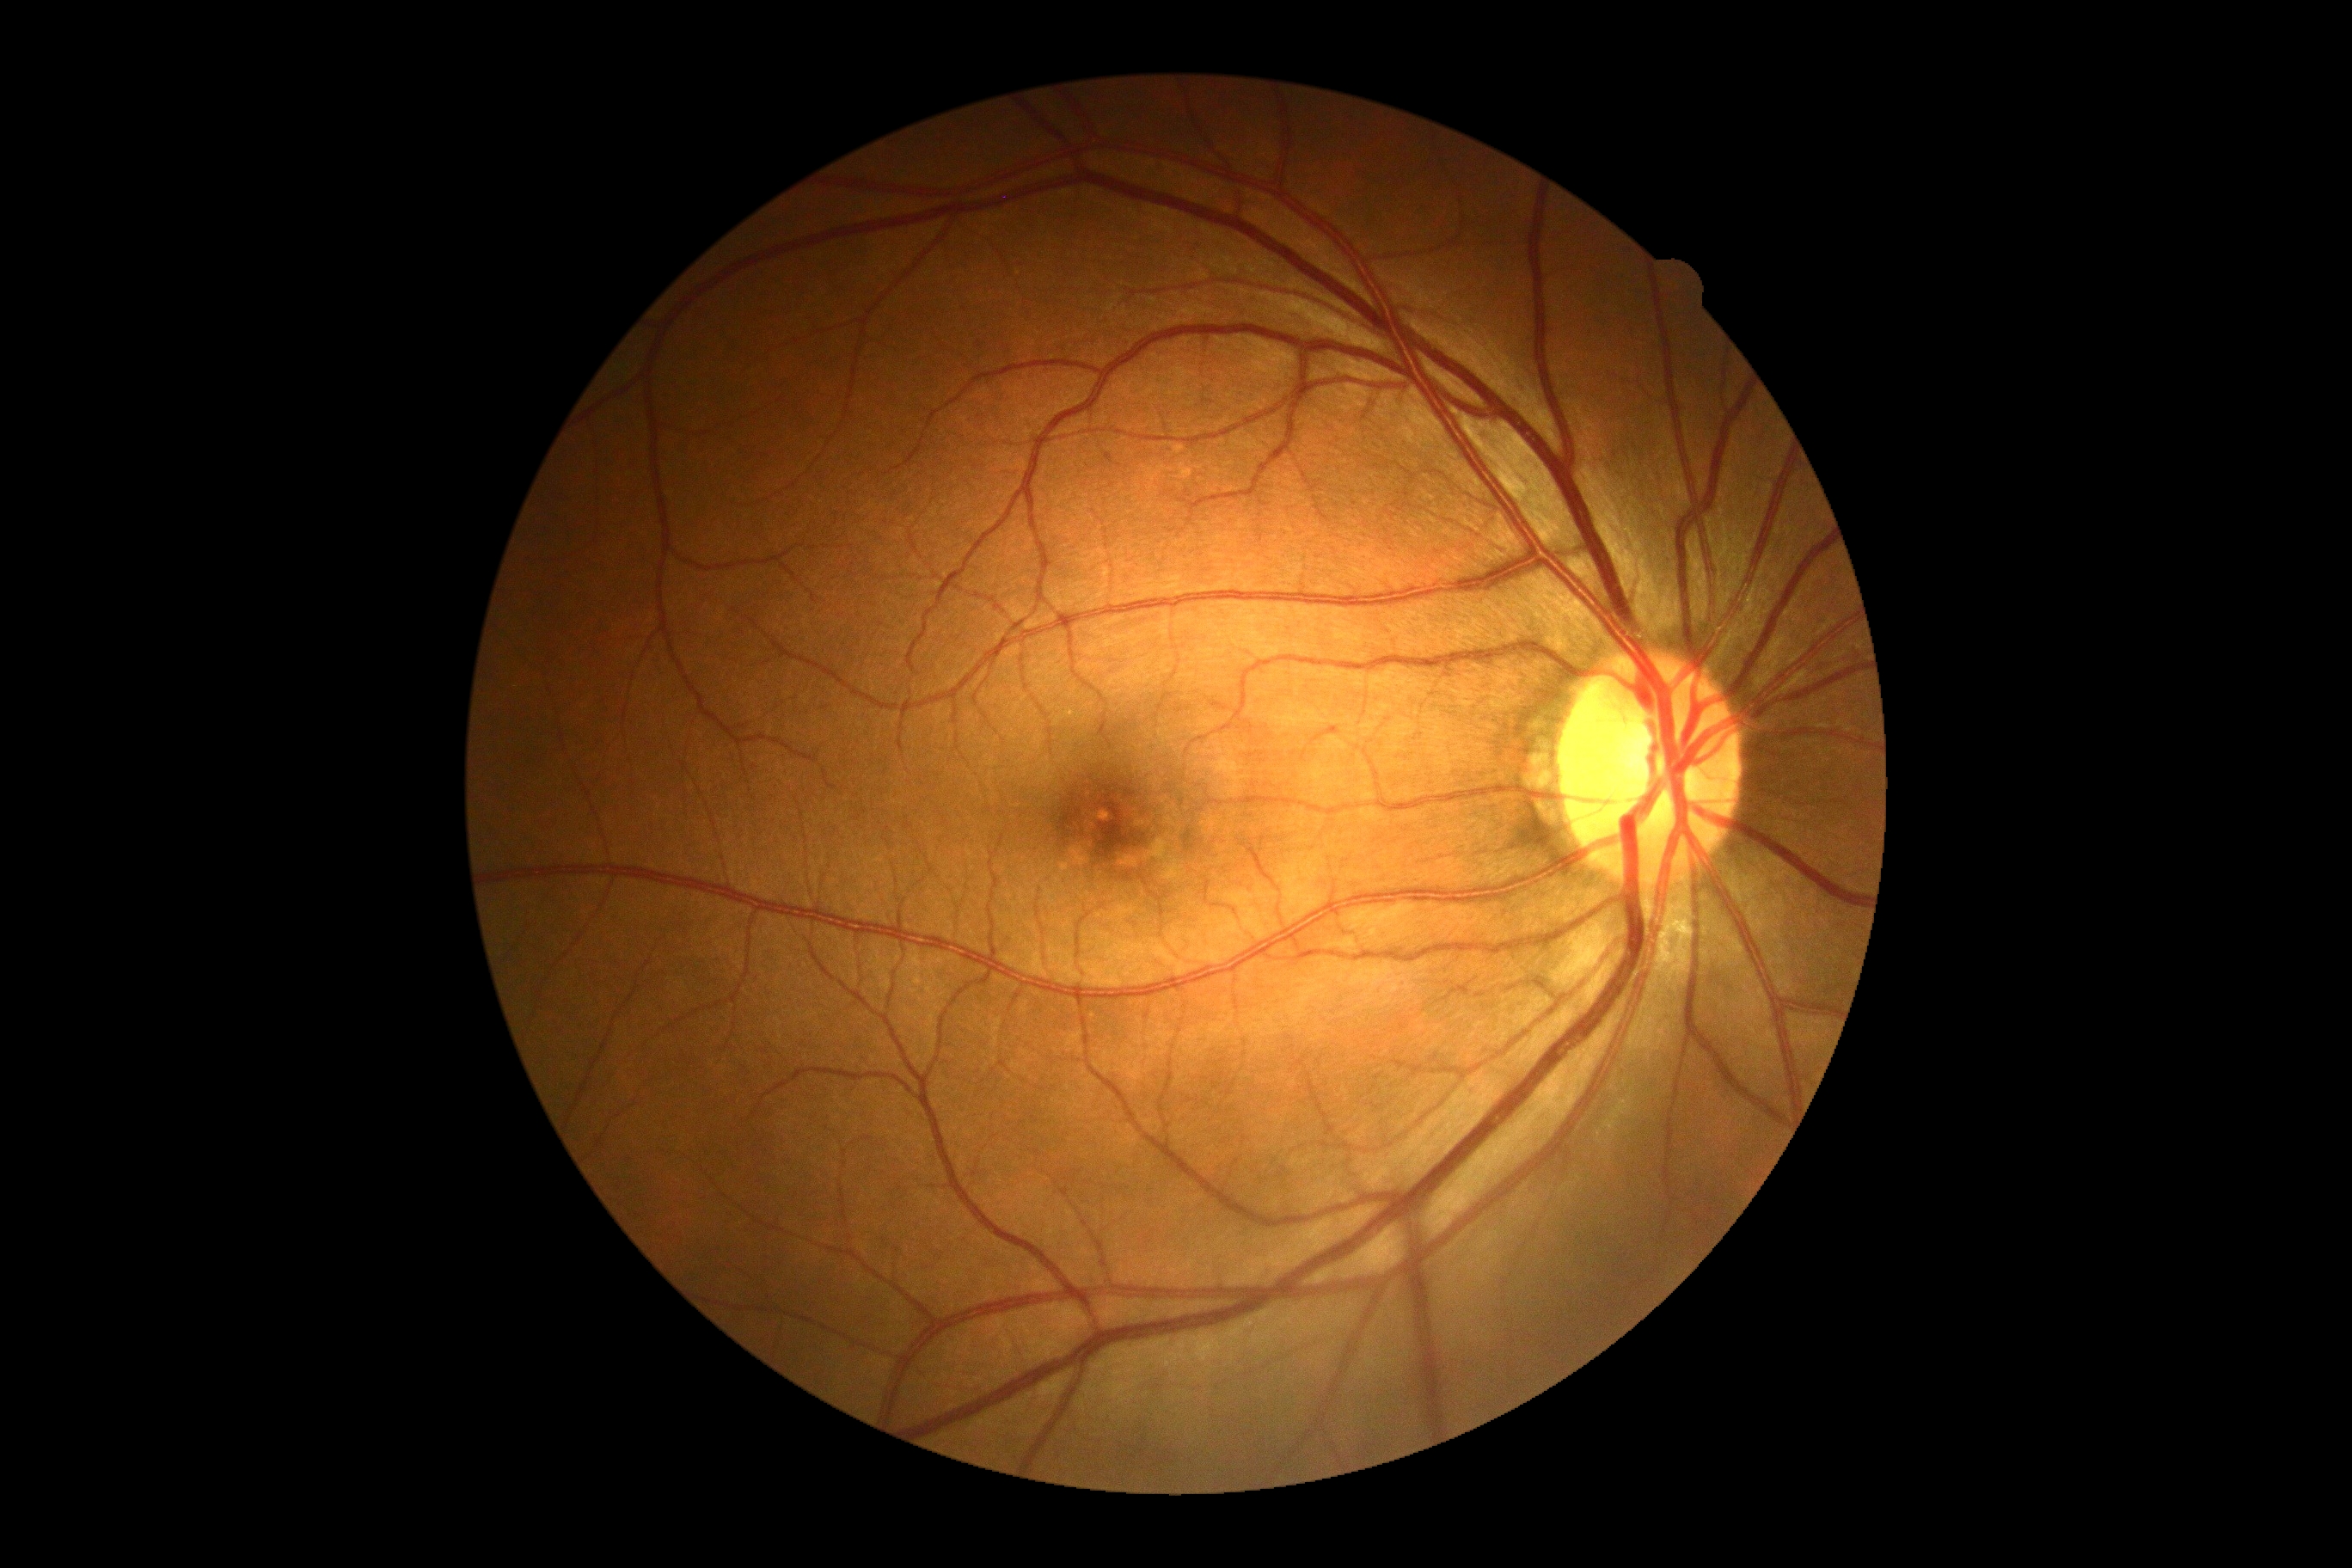
DR impression=no signs of DR, retinopathy=no apparent retinopathy (grade 0).